2361x1568px. Mydriatic (tropicamide 0.5%). Camera: Kowa VX-10α. Macula-centered. CFP:
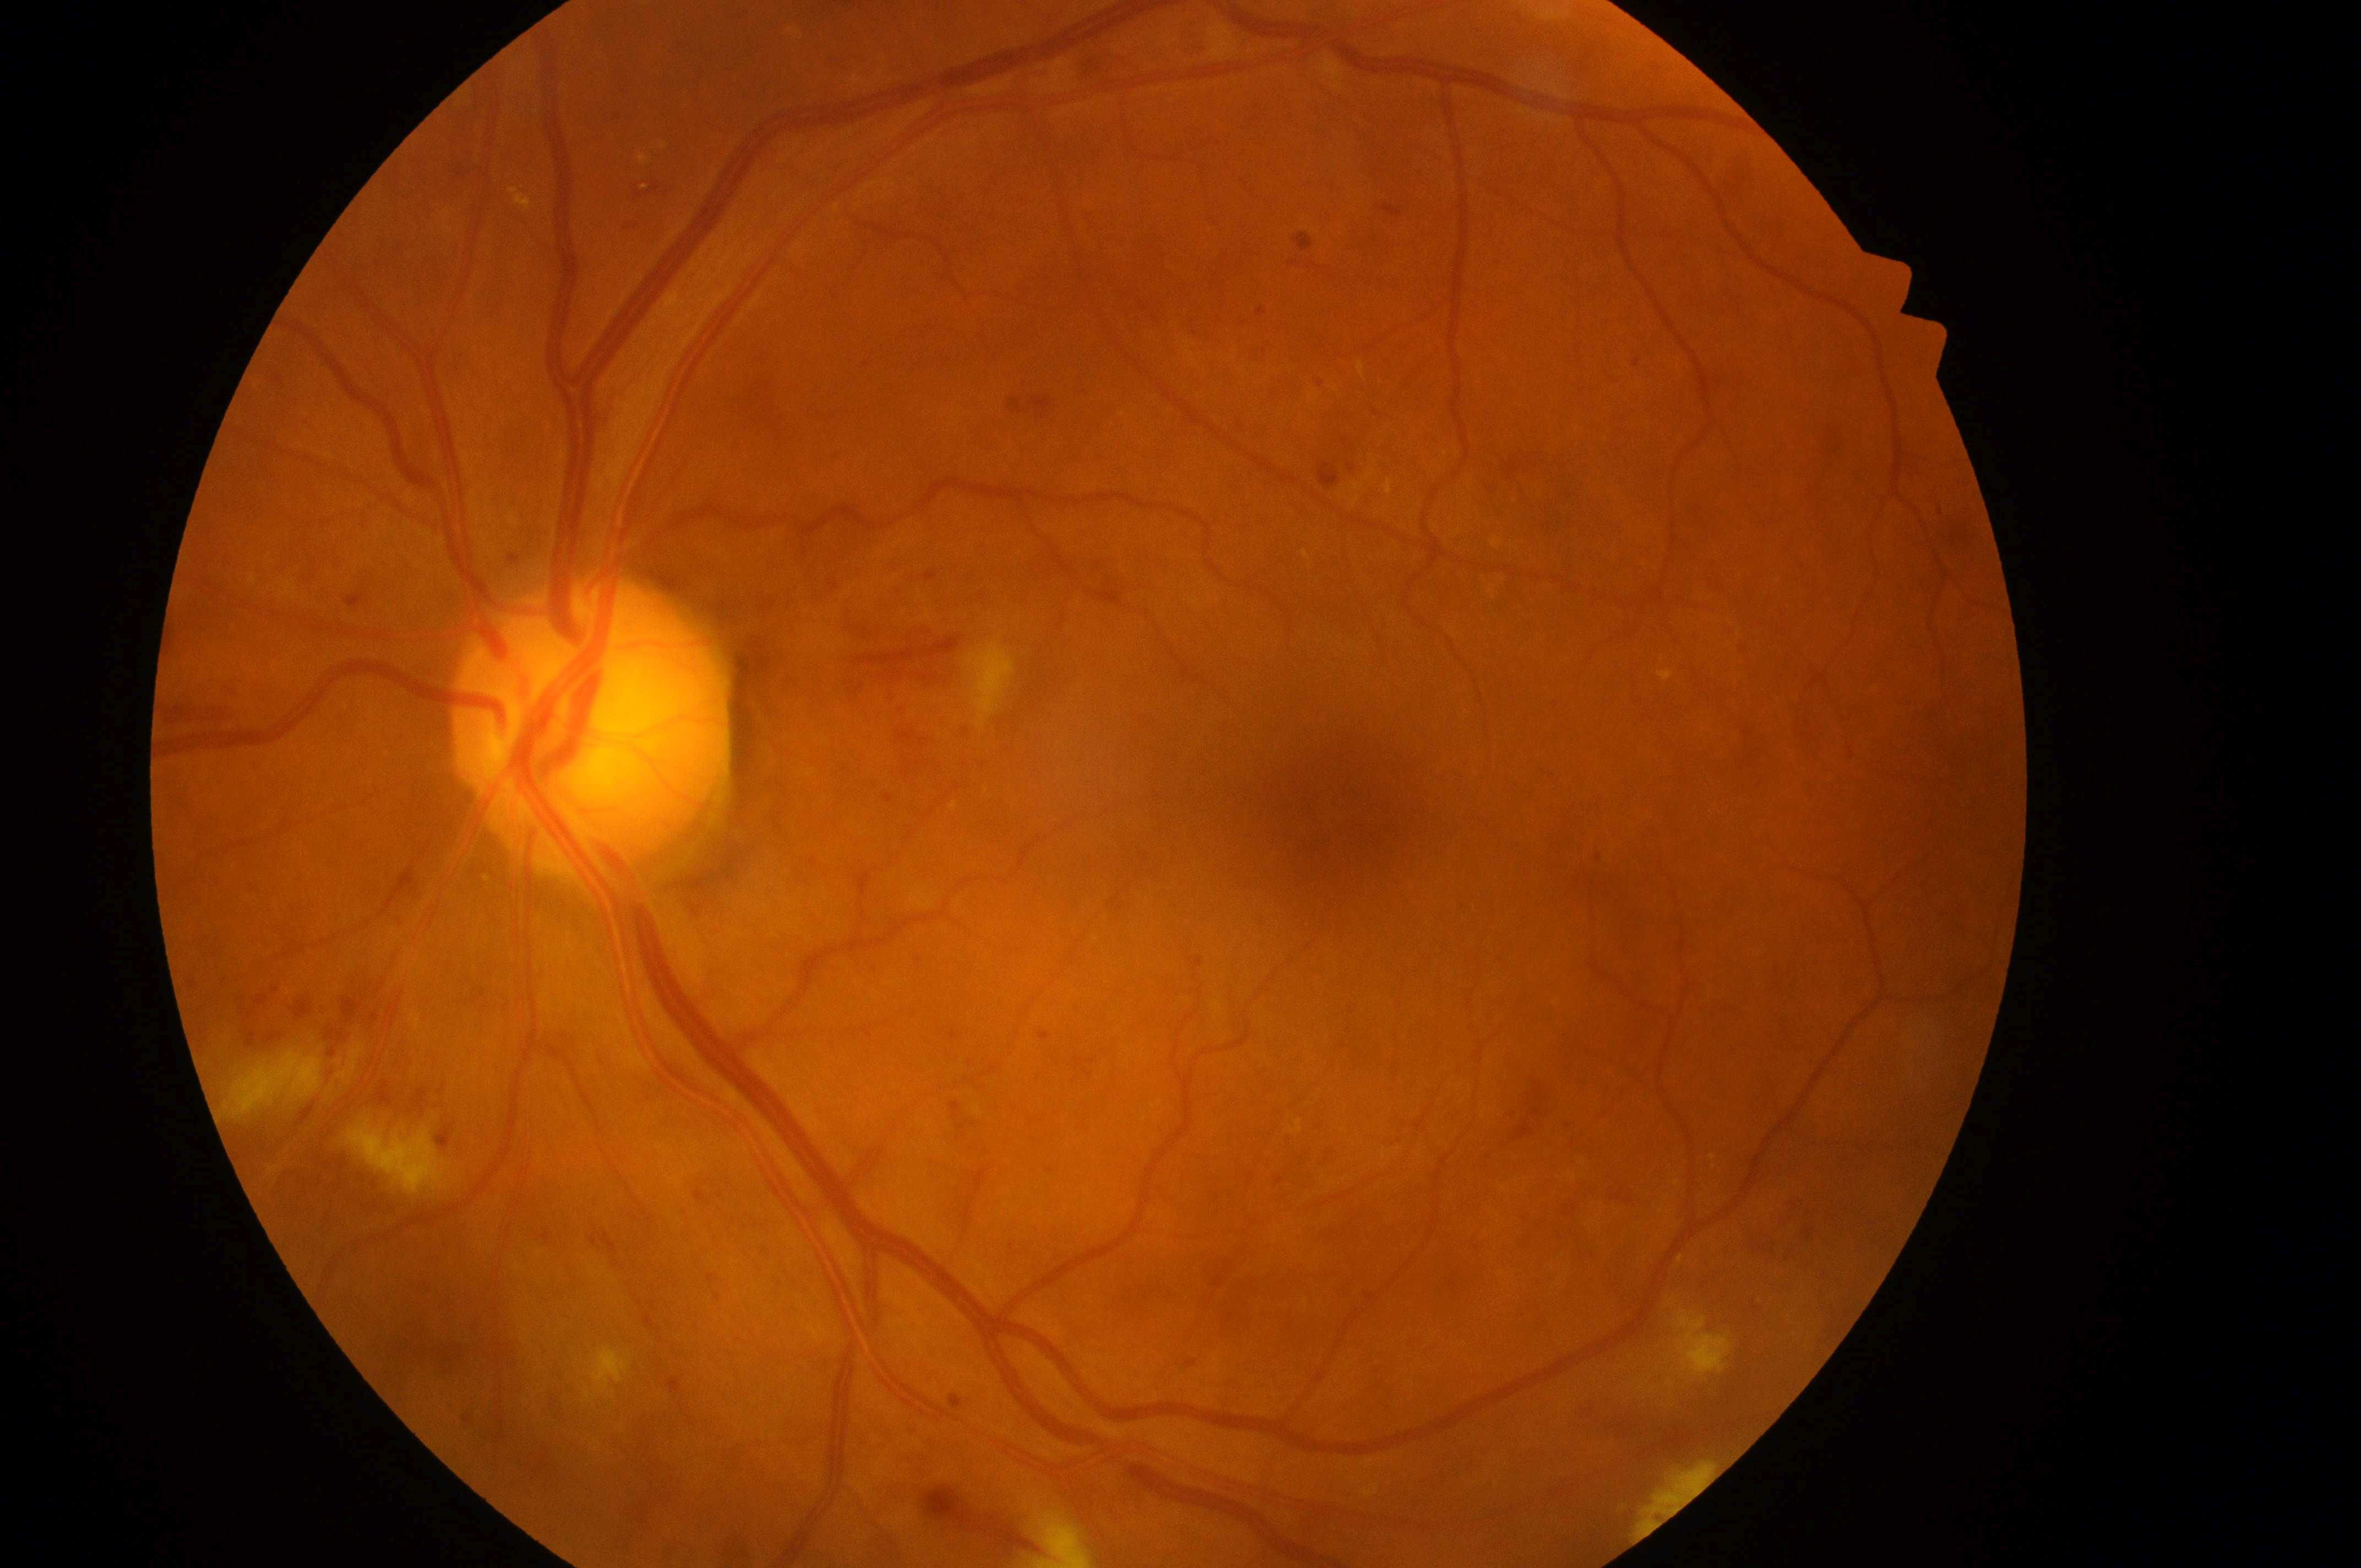

Findings:
- diabetic retinopathy severity · grade 3 (severe NPDR)
- macula center · (1339,825)
- laterality · left
- macular edema risk · grade 1 (low risk)
- disc center · (585,732)